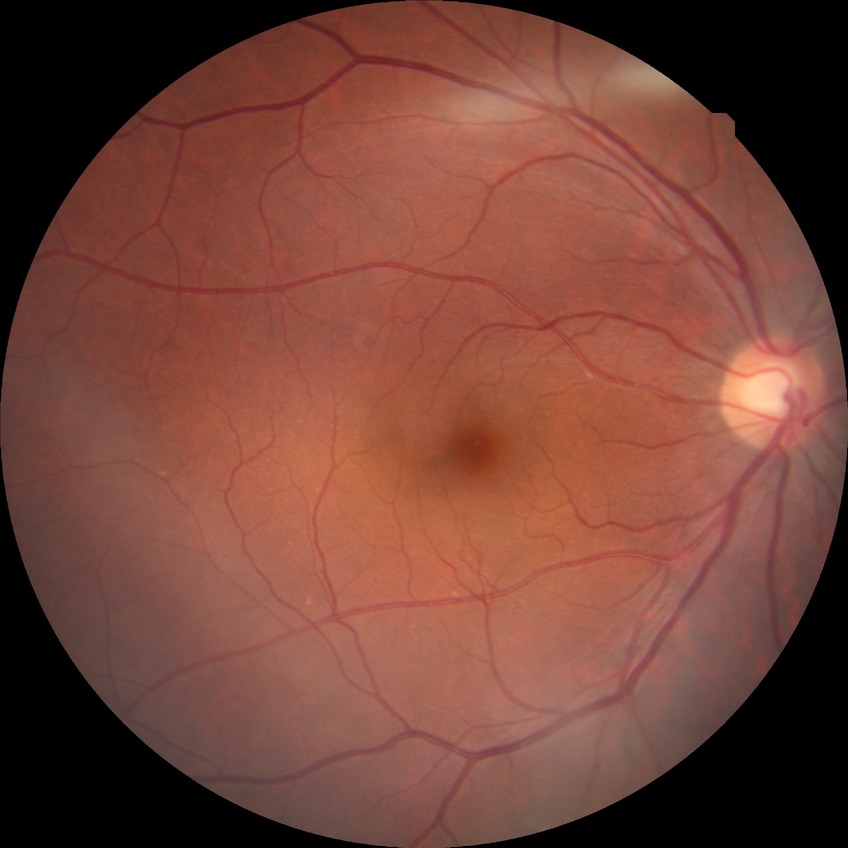
Modified Davis grading is no diabetic retinopathy.